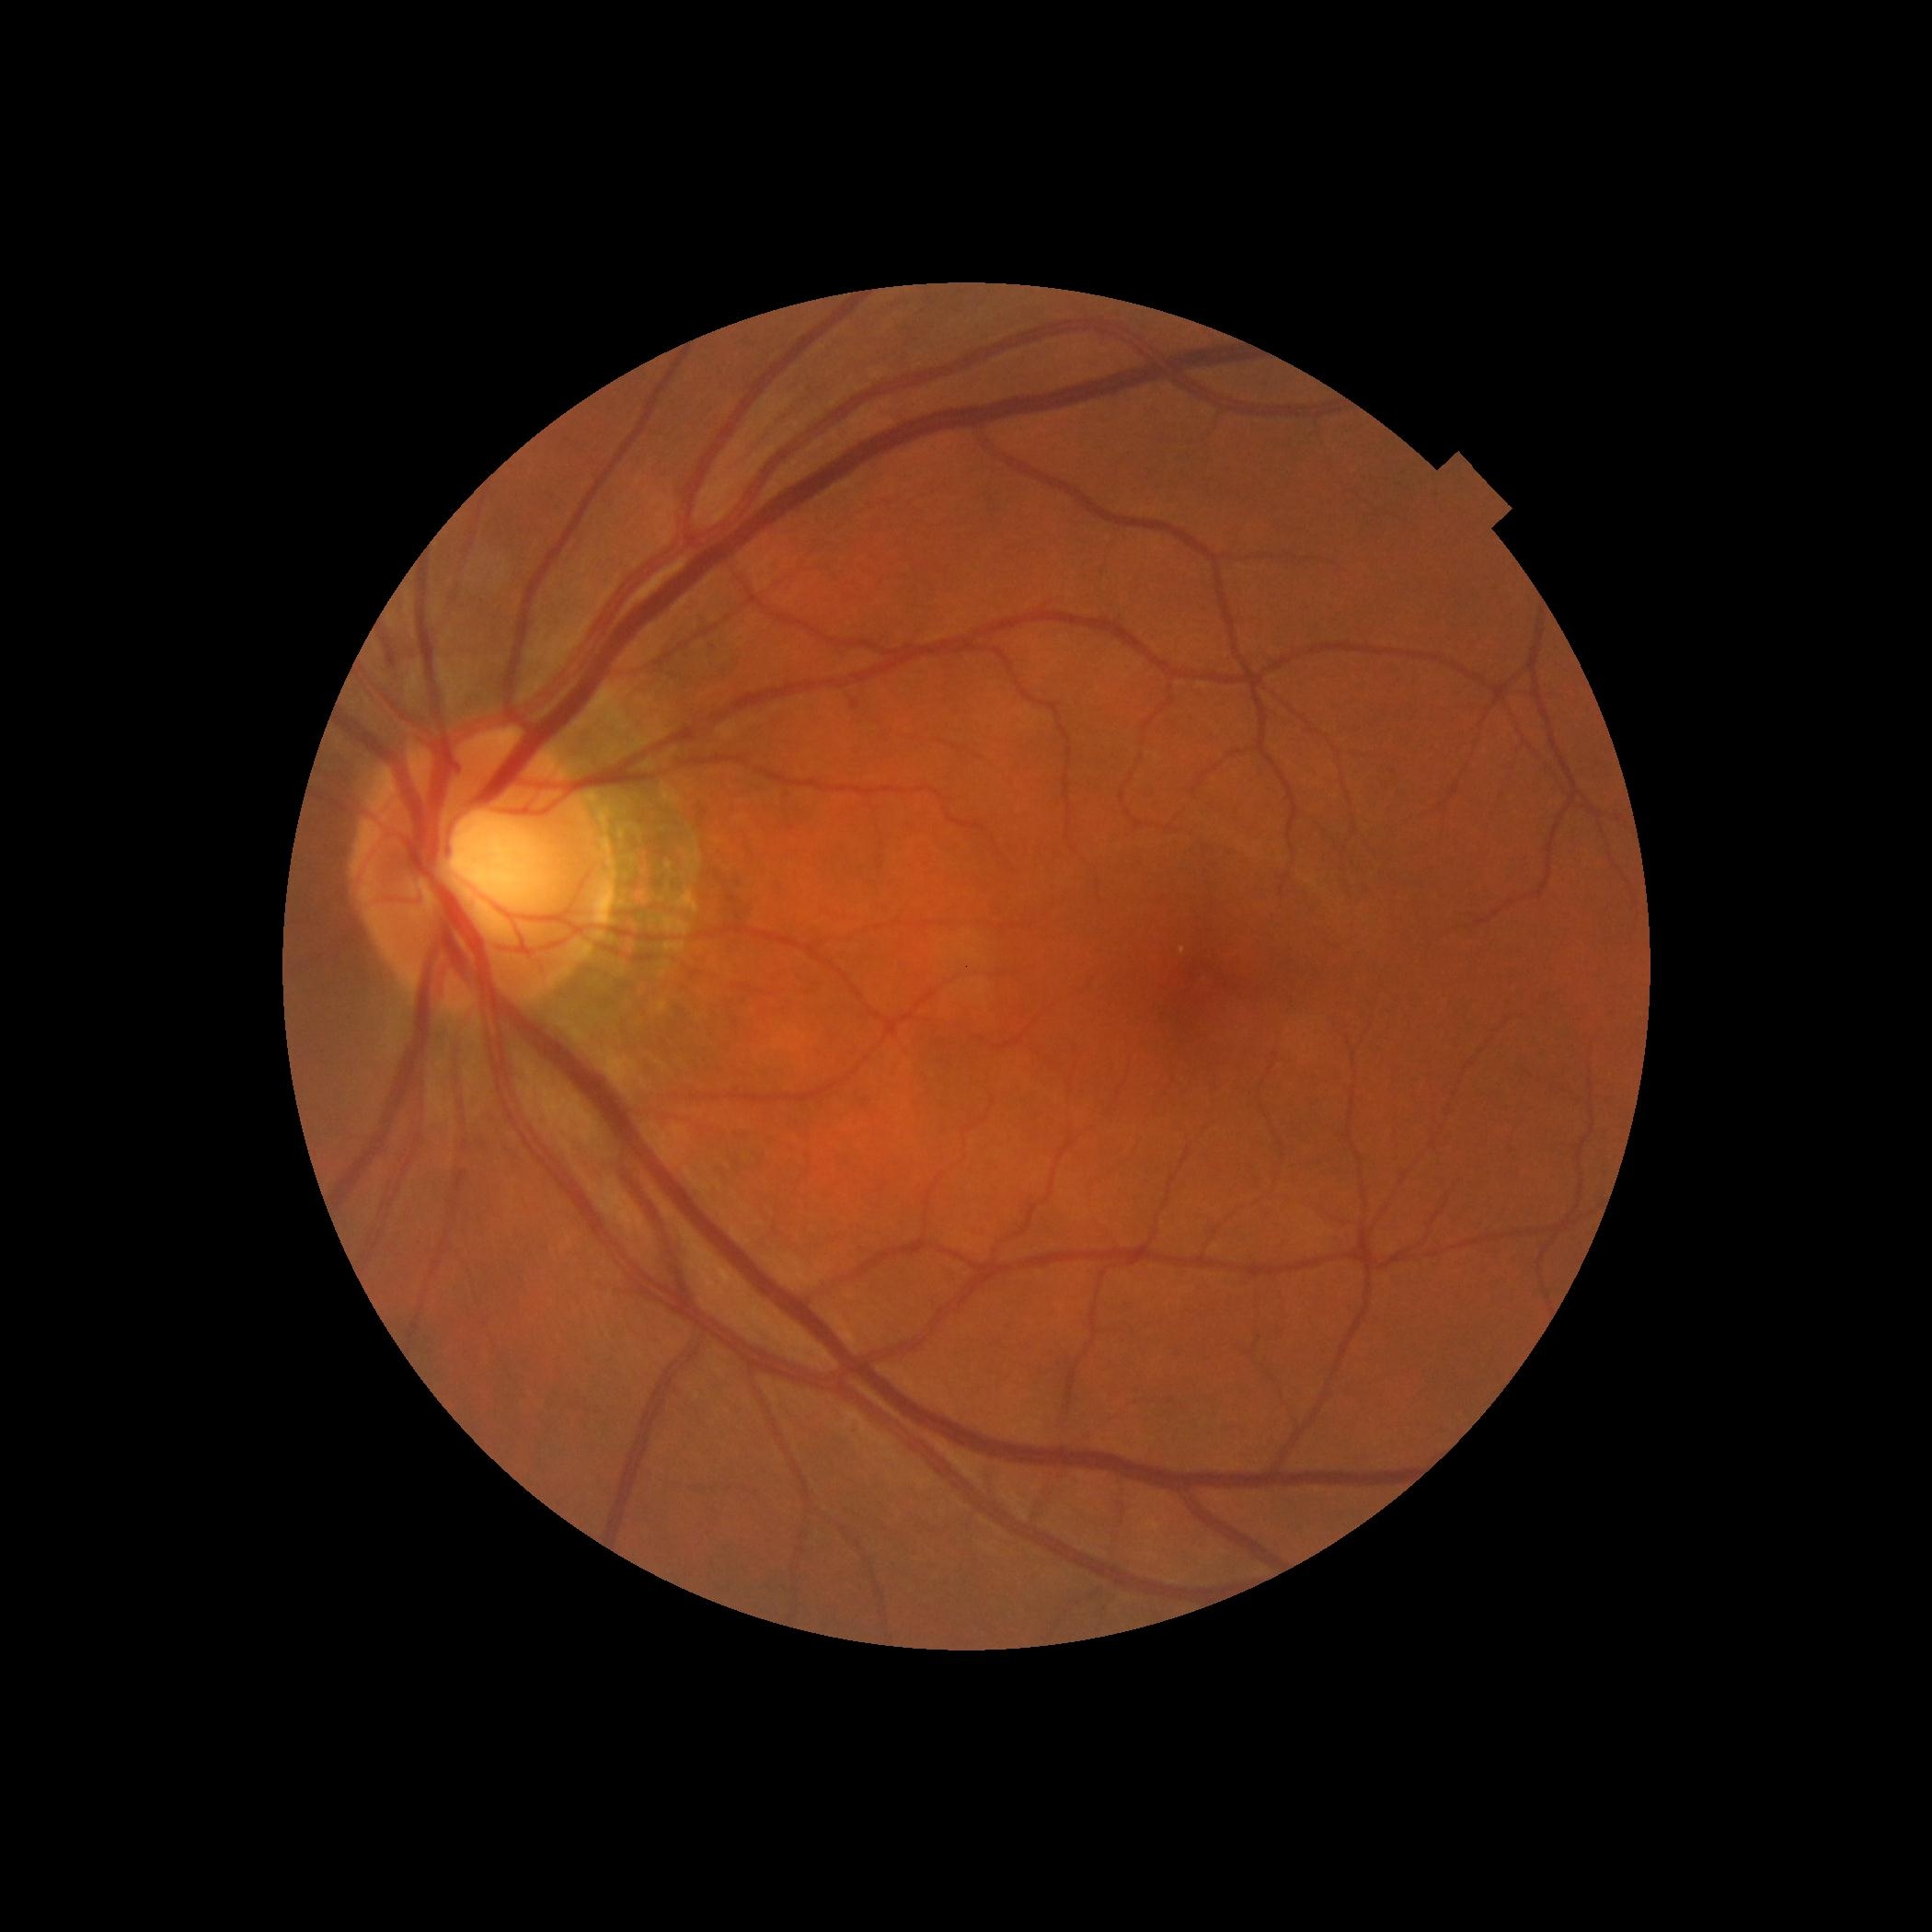

DR grade = no apparent diabetic retinopathy (0)
DR impression = negative for DR